45° FOV, 2352 by 1568 pixels.
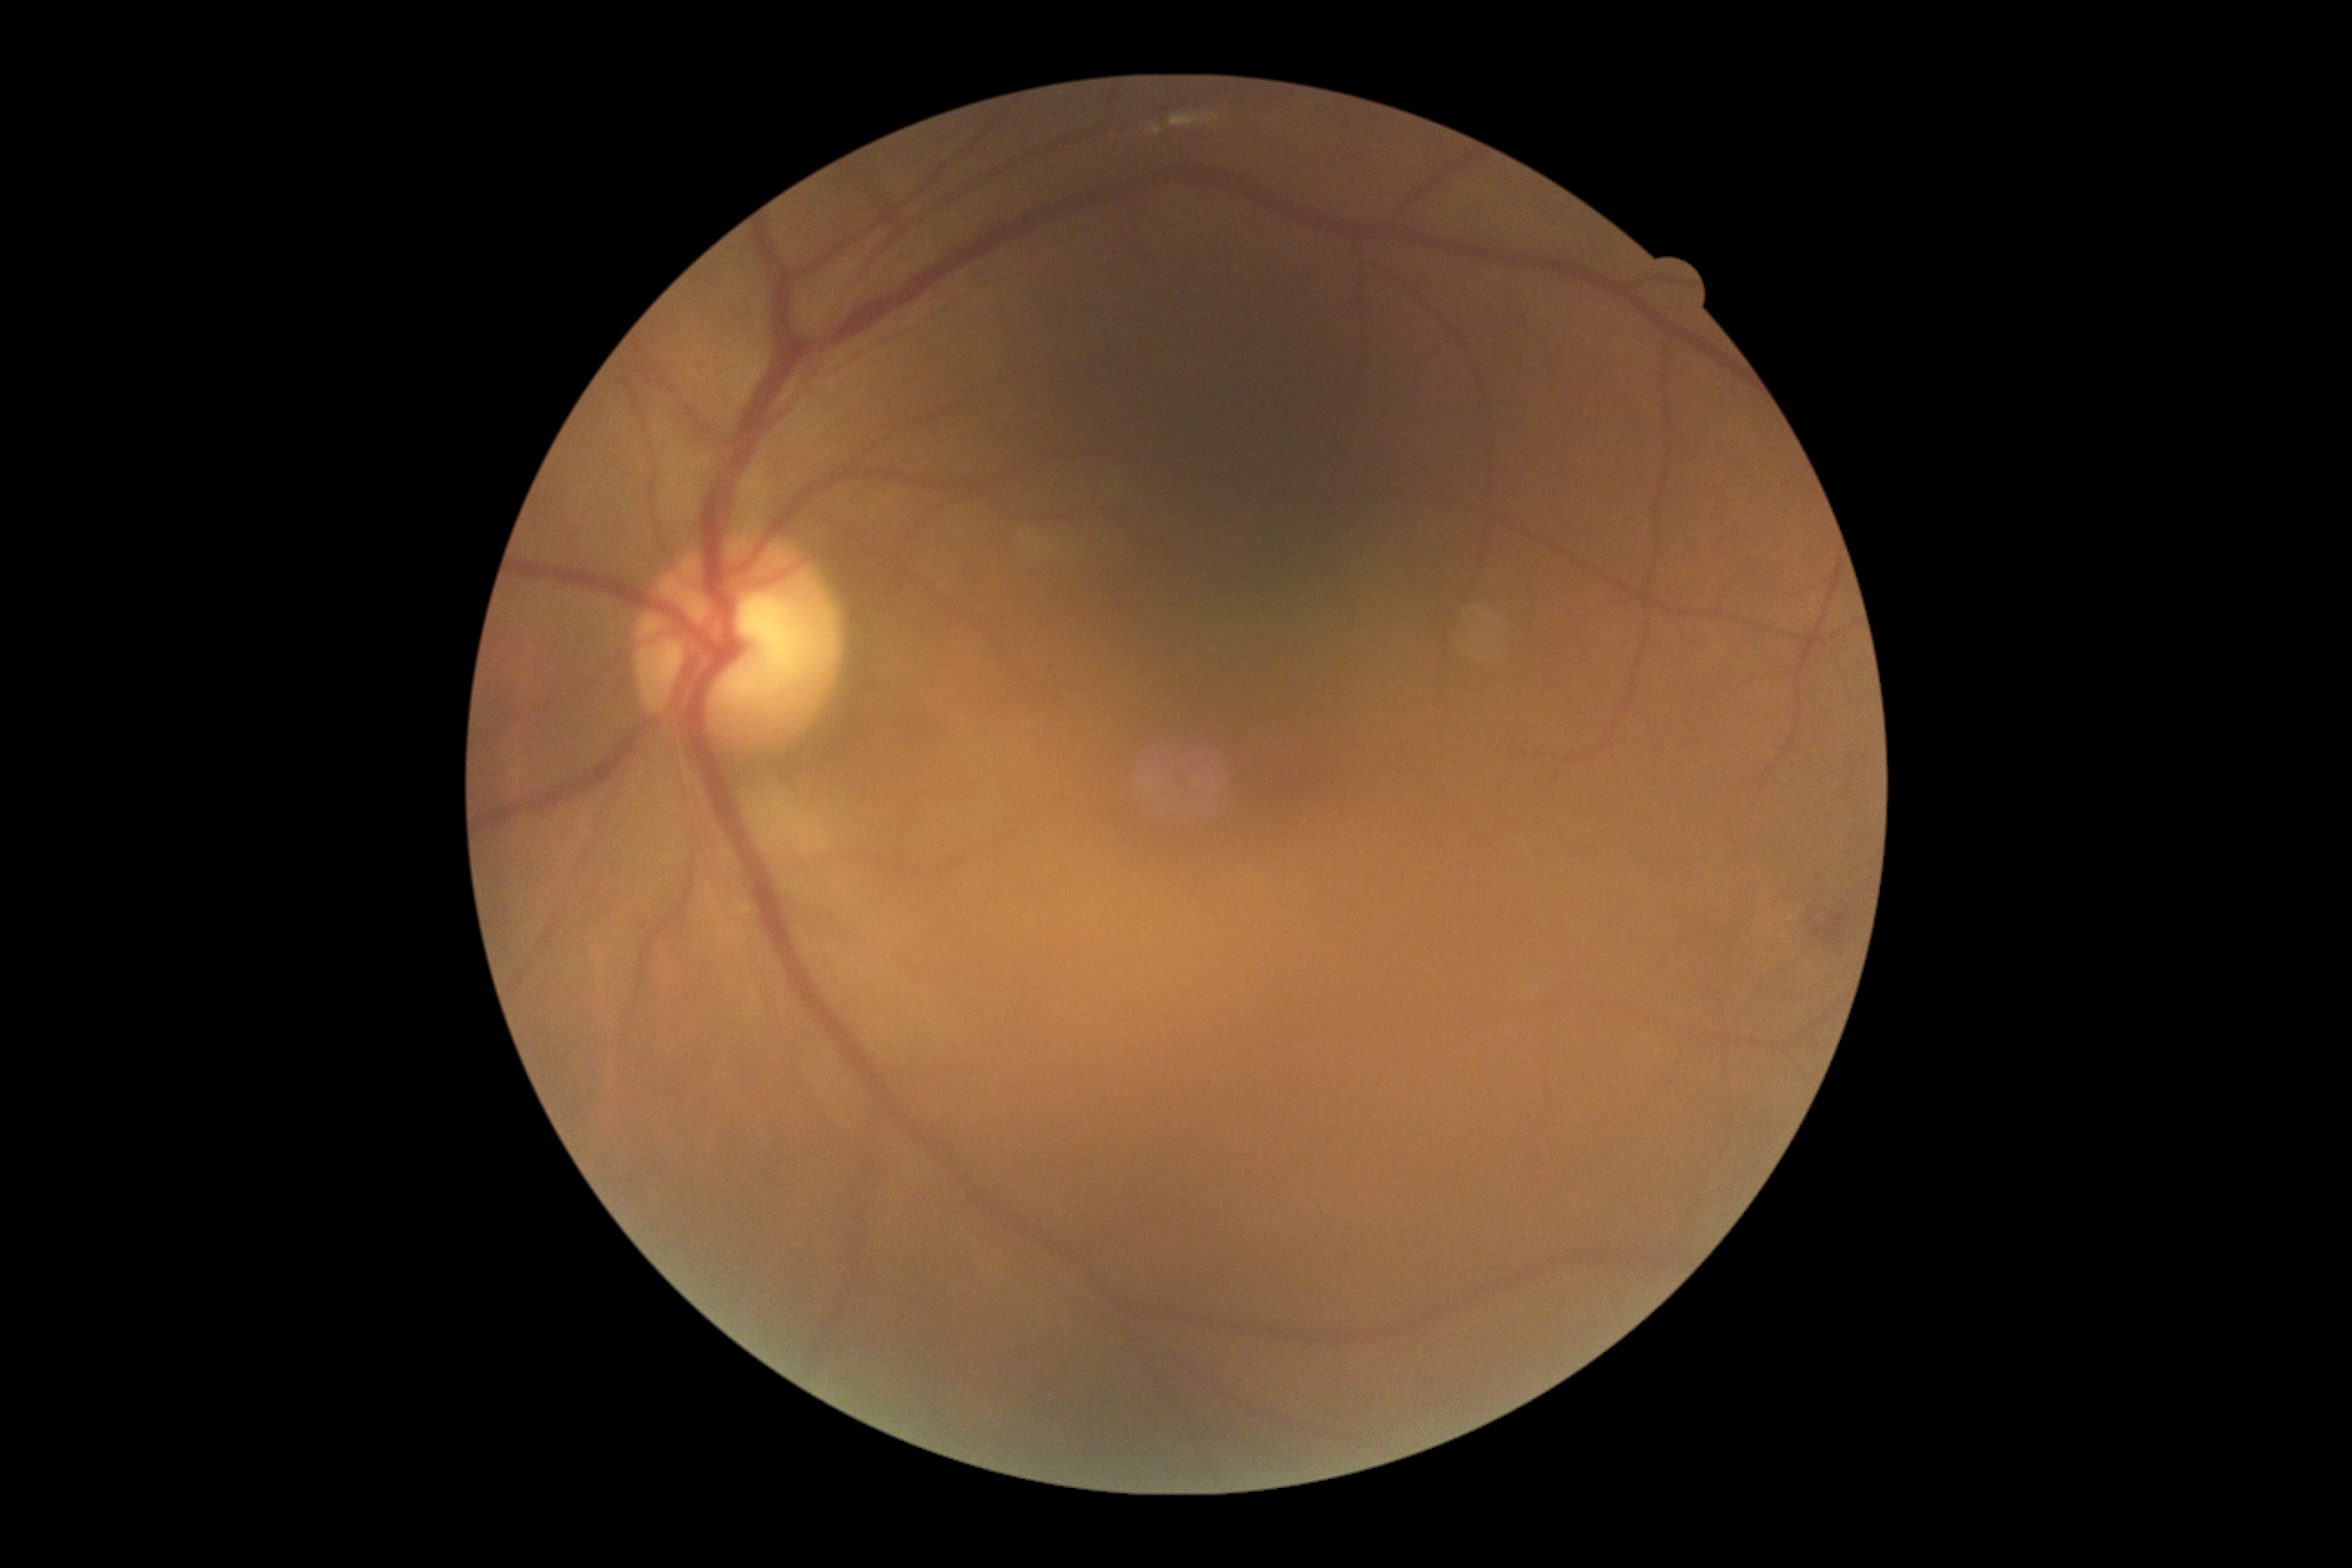
DR is grade 2 — more than just microaneurysms but less than severe NPDR.